Captured without pupil dilation, camera: Nidek AFC-330: 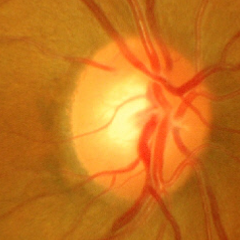
Assessment = advanced-stage glaucoma. Diagnostic criteria: near-total cupping of the optic nerve head, with or without severe visual field loss within the central 10 degrees of fixation.